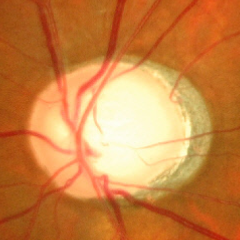
Glaucoma stage: advanced glaucomatous optic neuropathy.